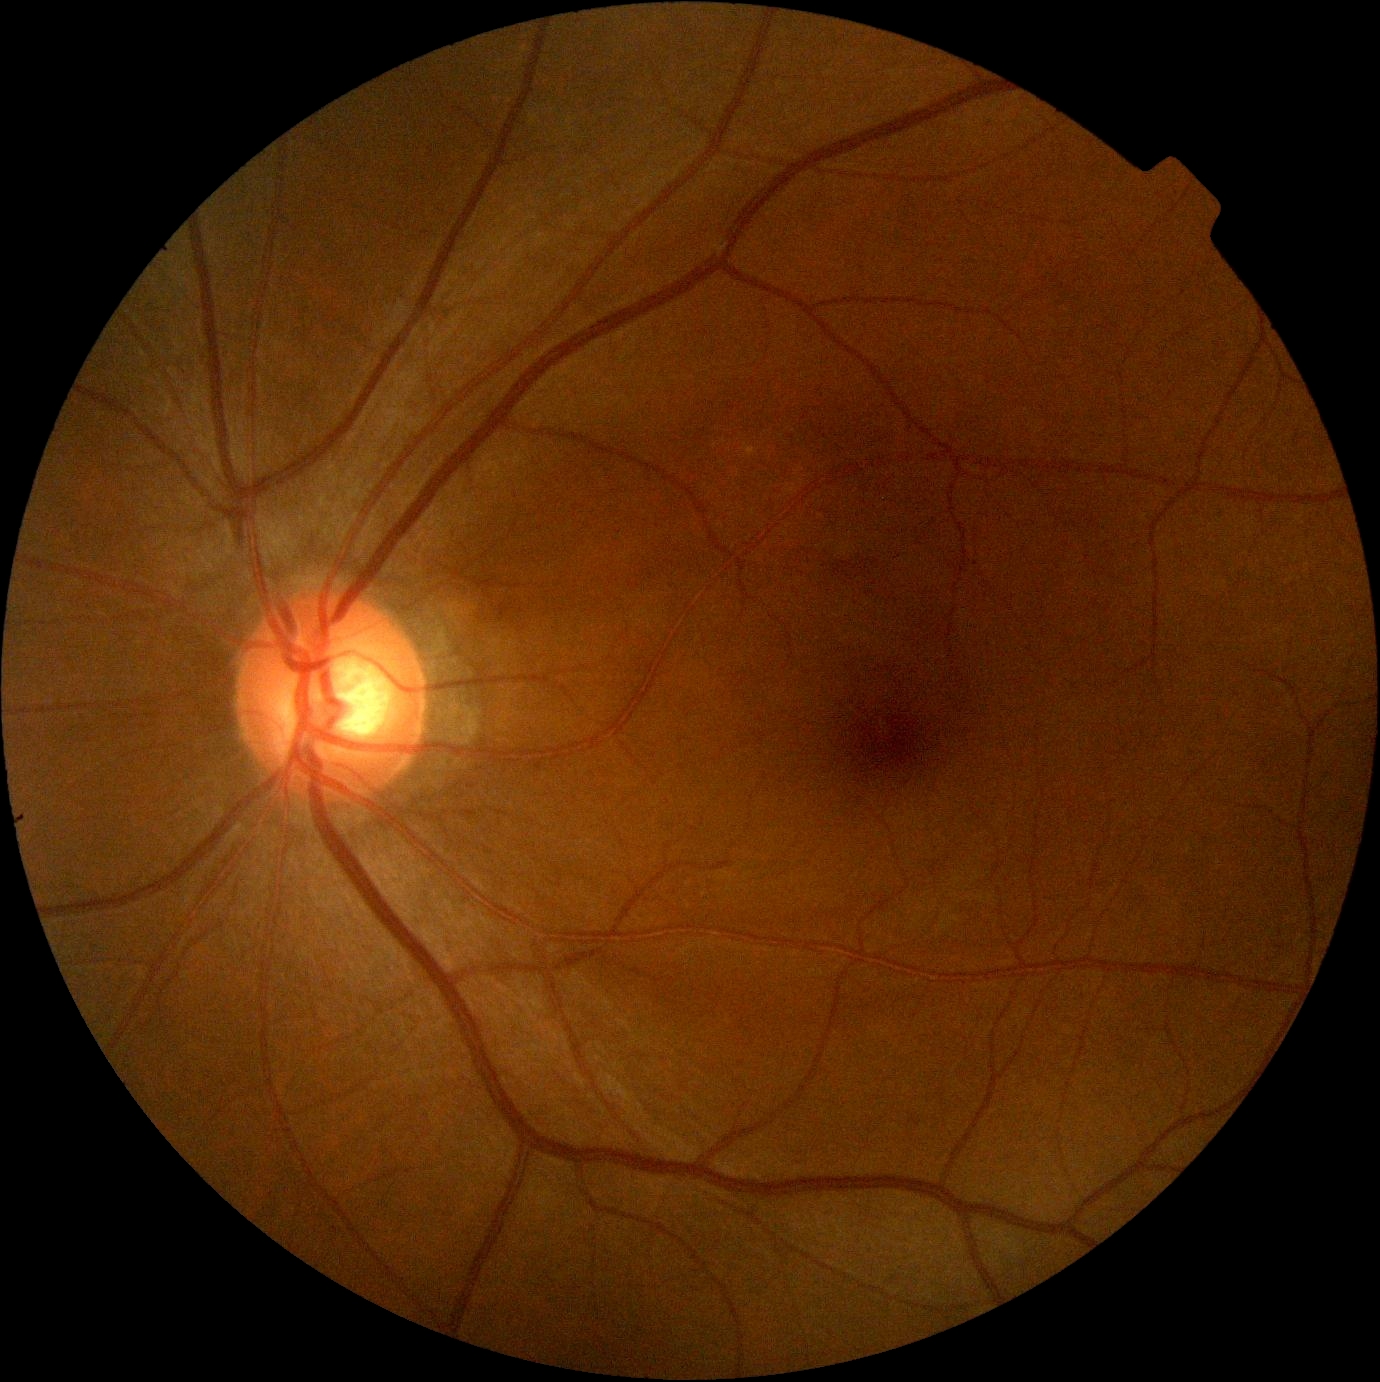

No signs of diabetic retinopathy. Retinopathy grade: 0.